Wide-field fundus image from infant ROP screening — 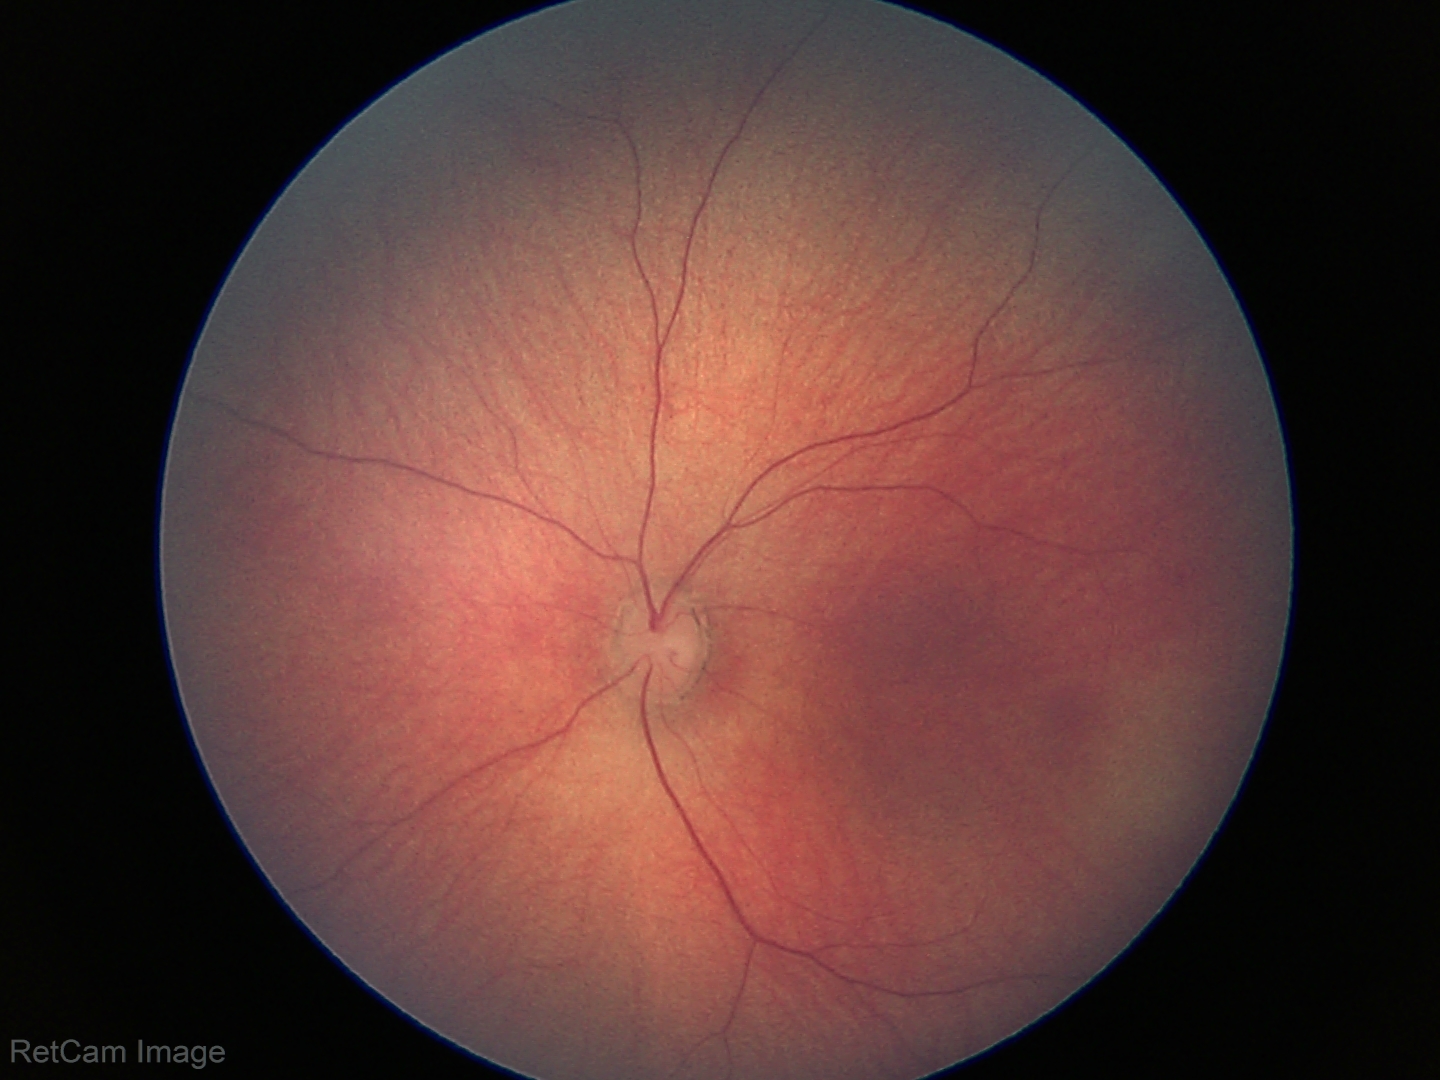 Screening diagnosis: physiological appearance.